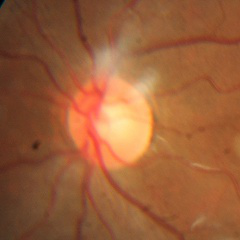
This fundus photograph shows no glaucoma.